45° field of view · image size 2352x1568: 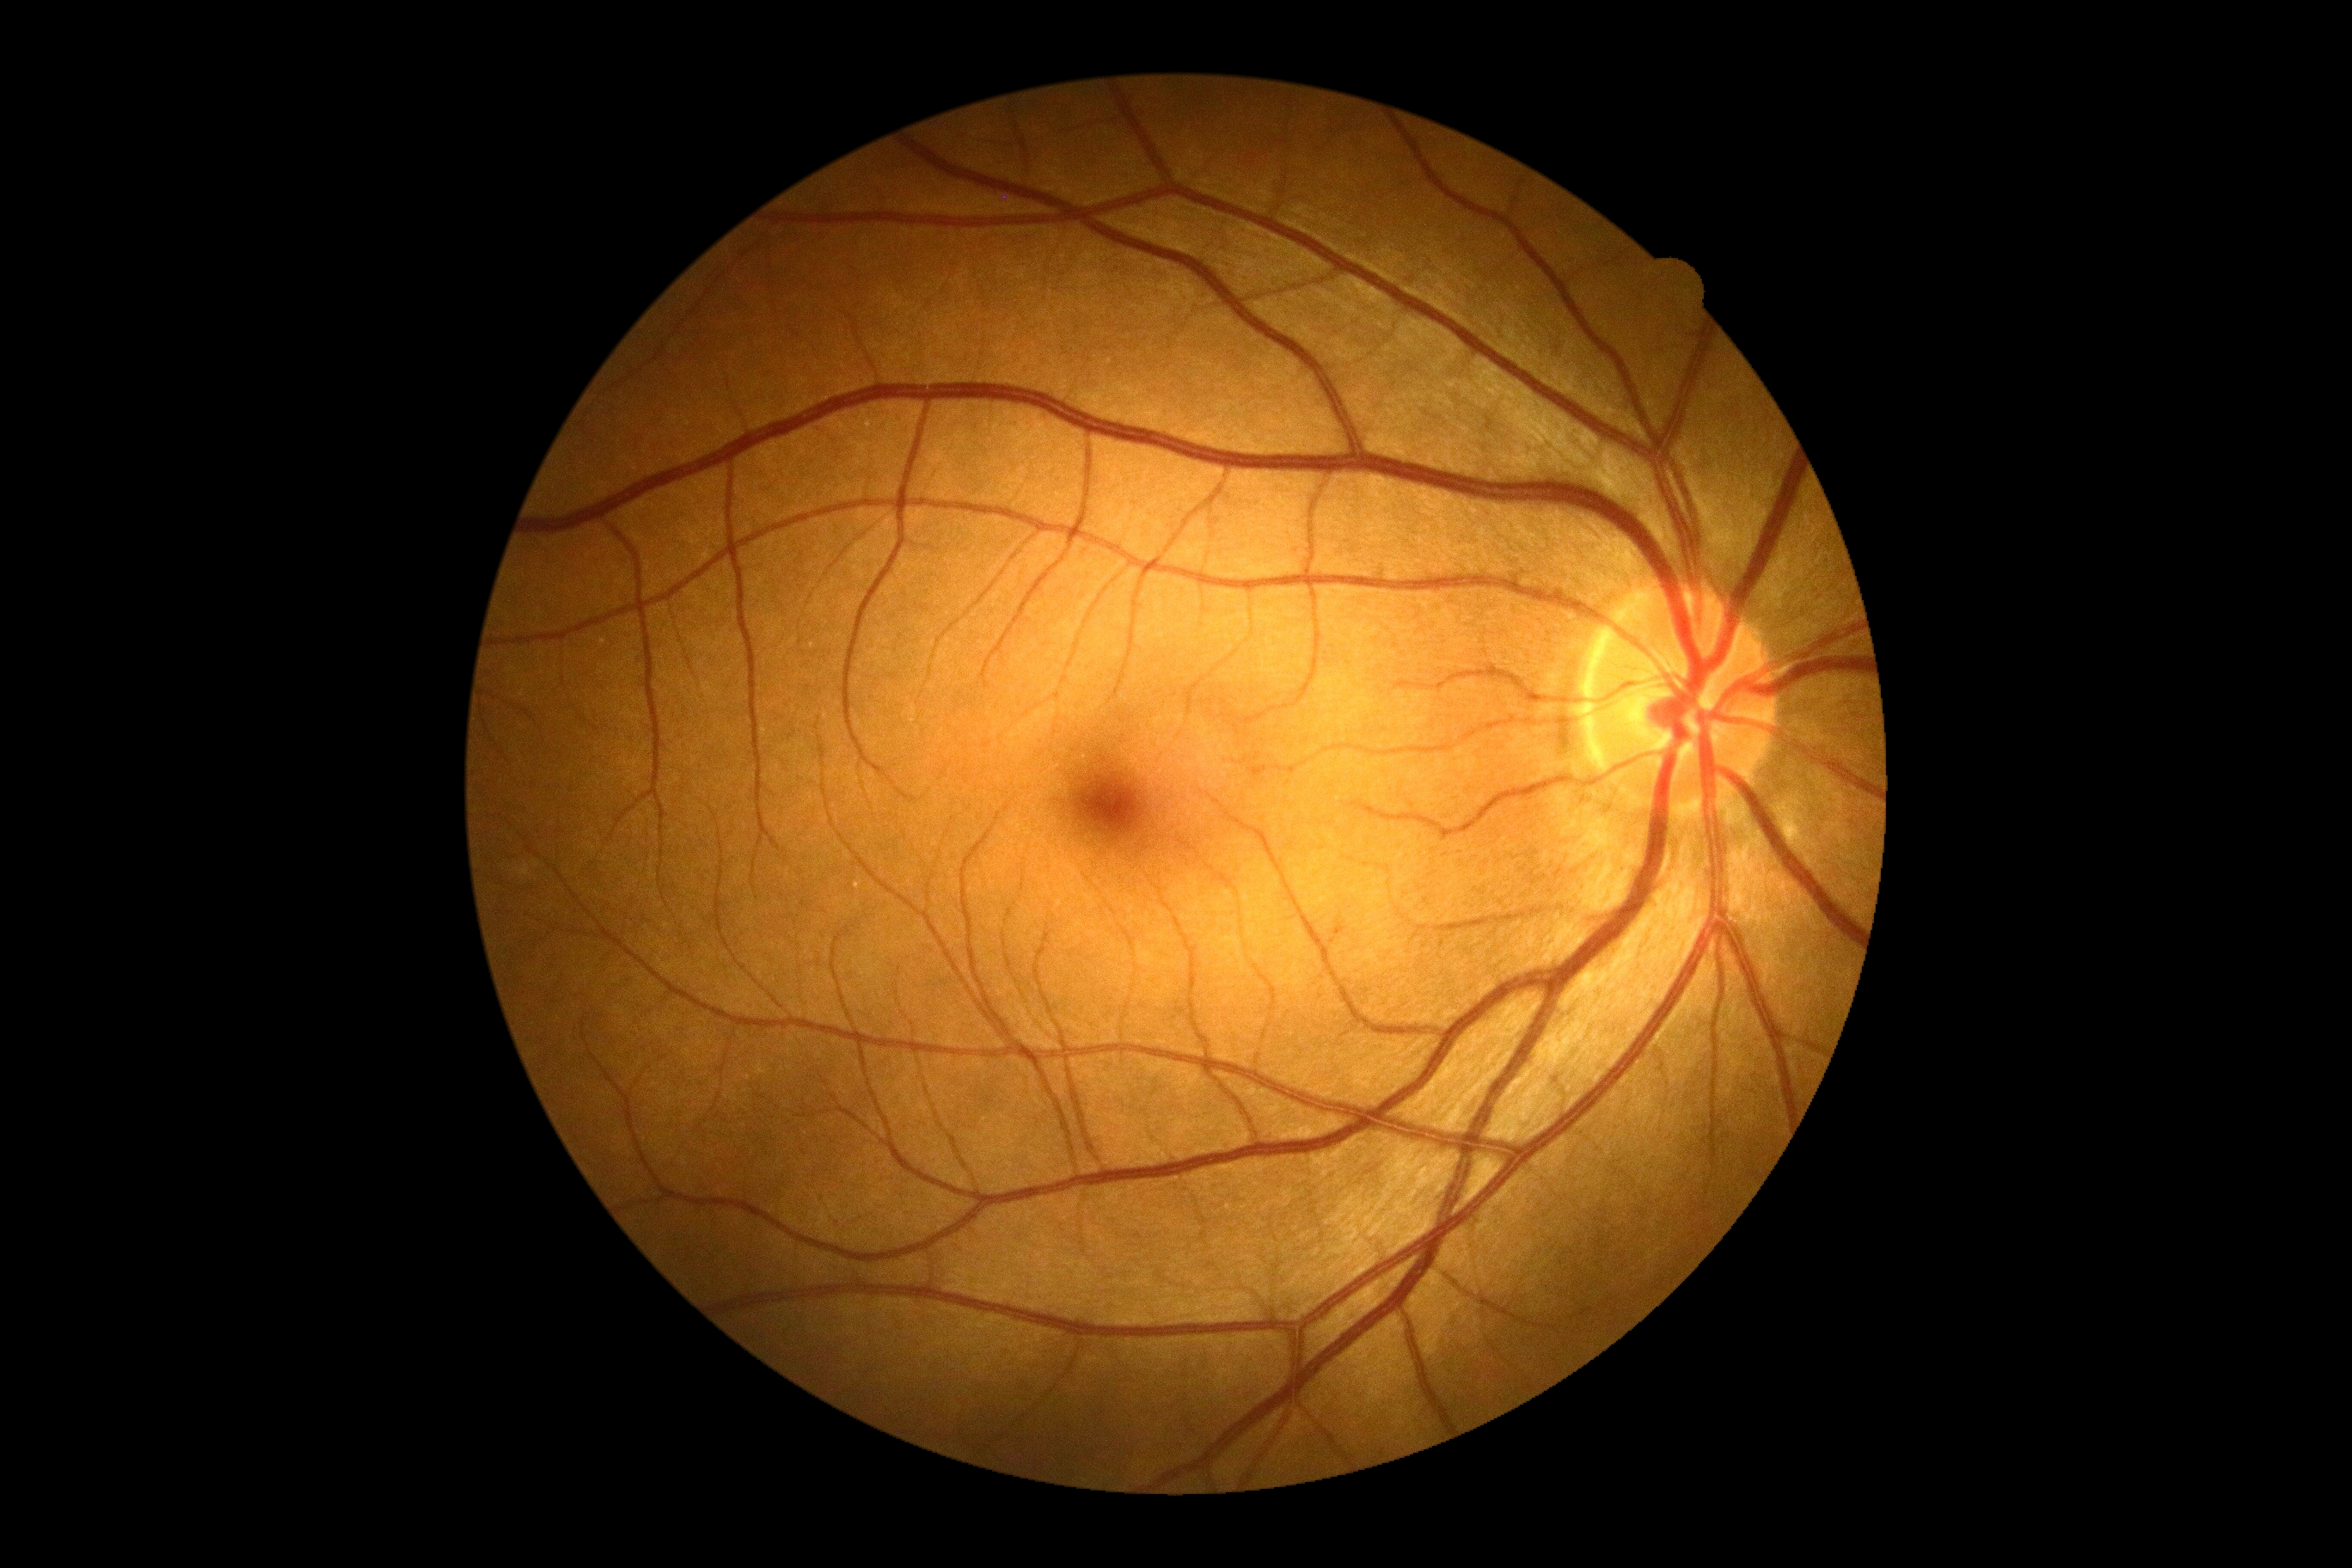

{
  "dr_grade": "0 — no visible signs of diabetic retinopathy",
  "dr_impression": "negative for DR"
}